1240 by 1240 pixels; wide-field fundus image from infant ROP screening:
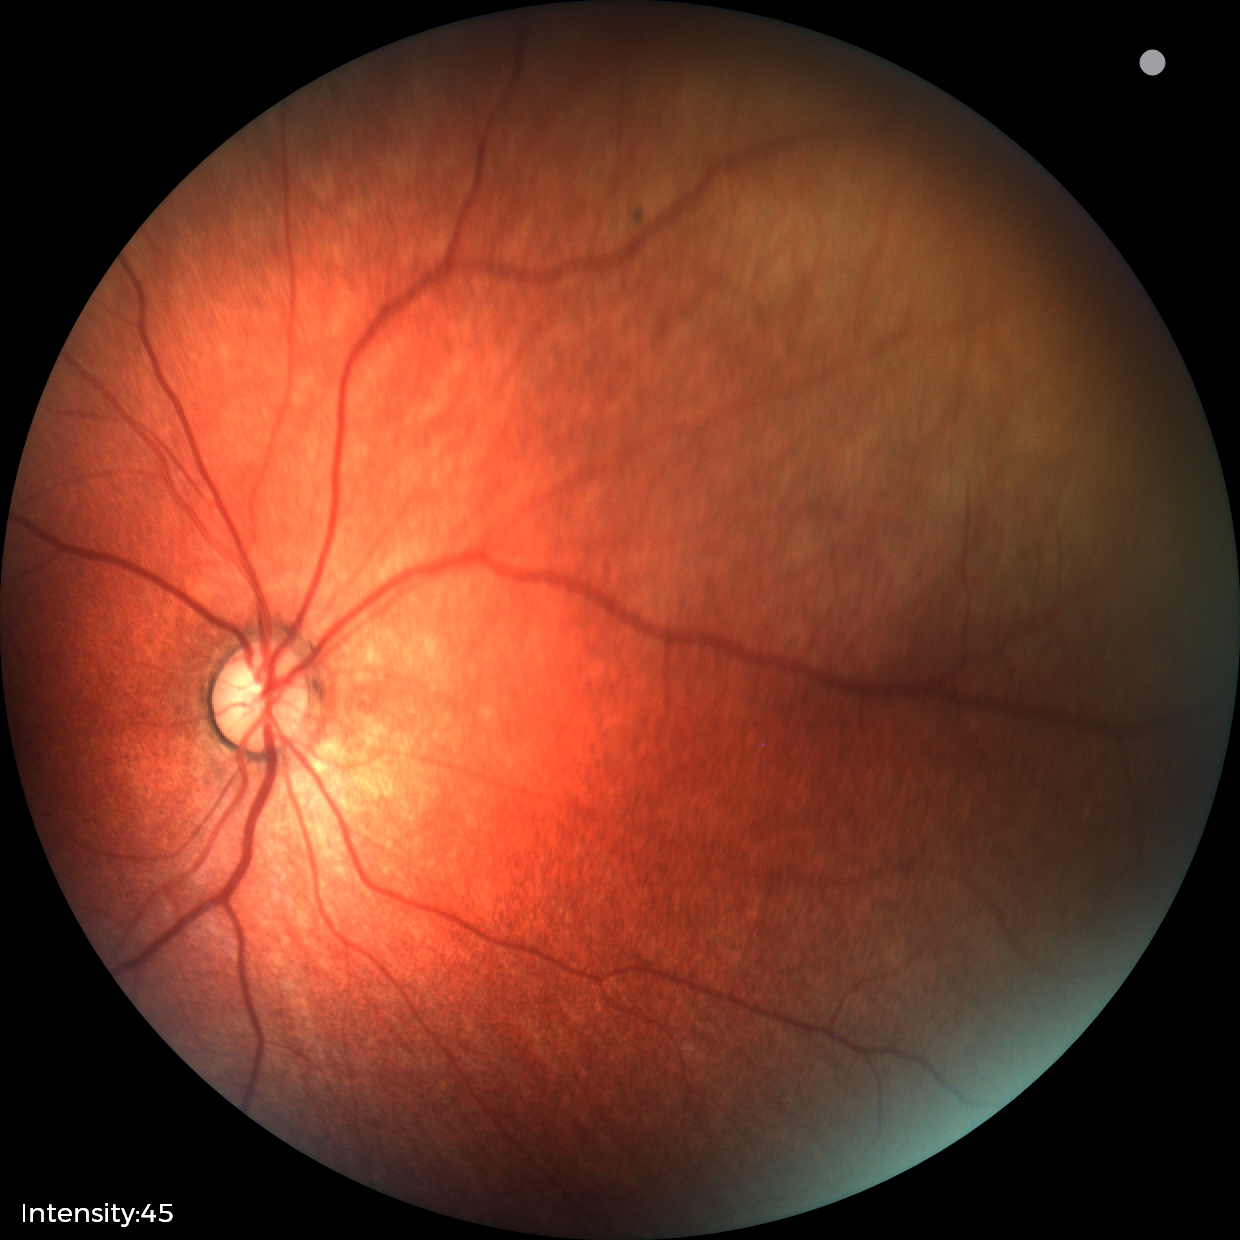
Normal screening examination.